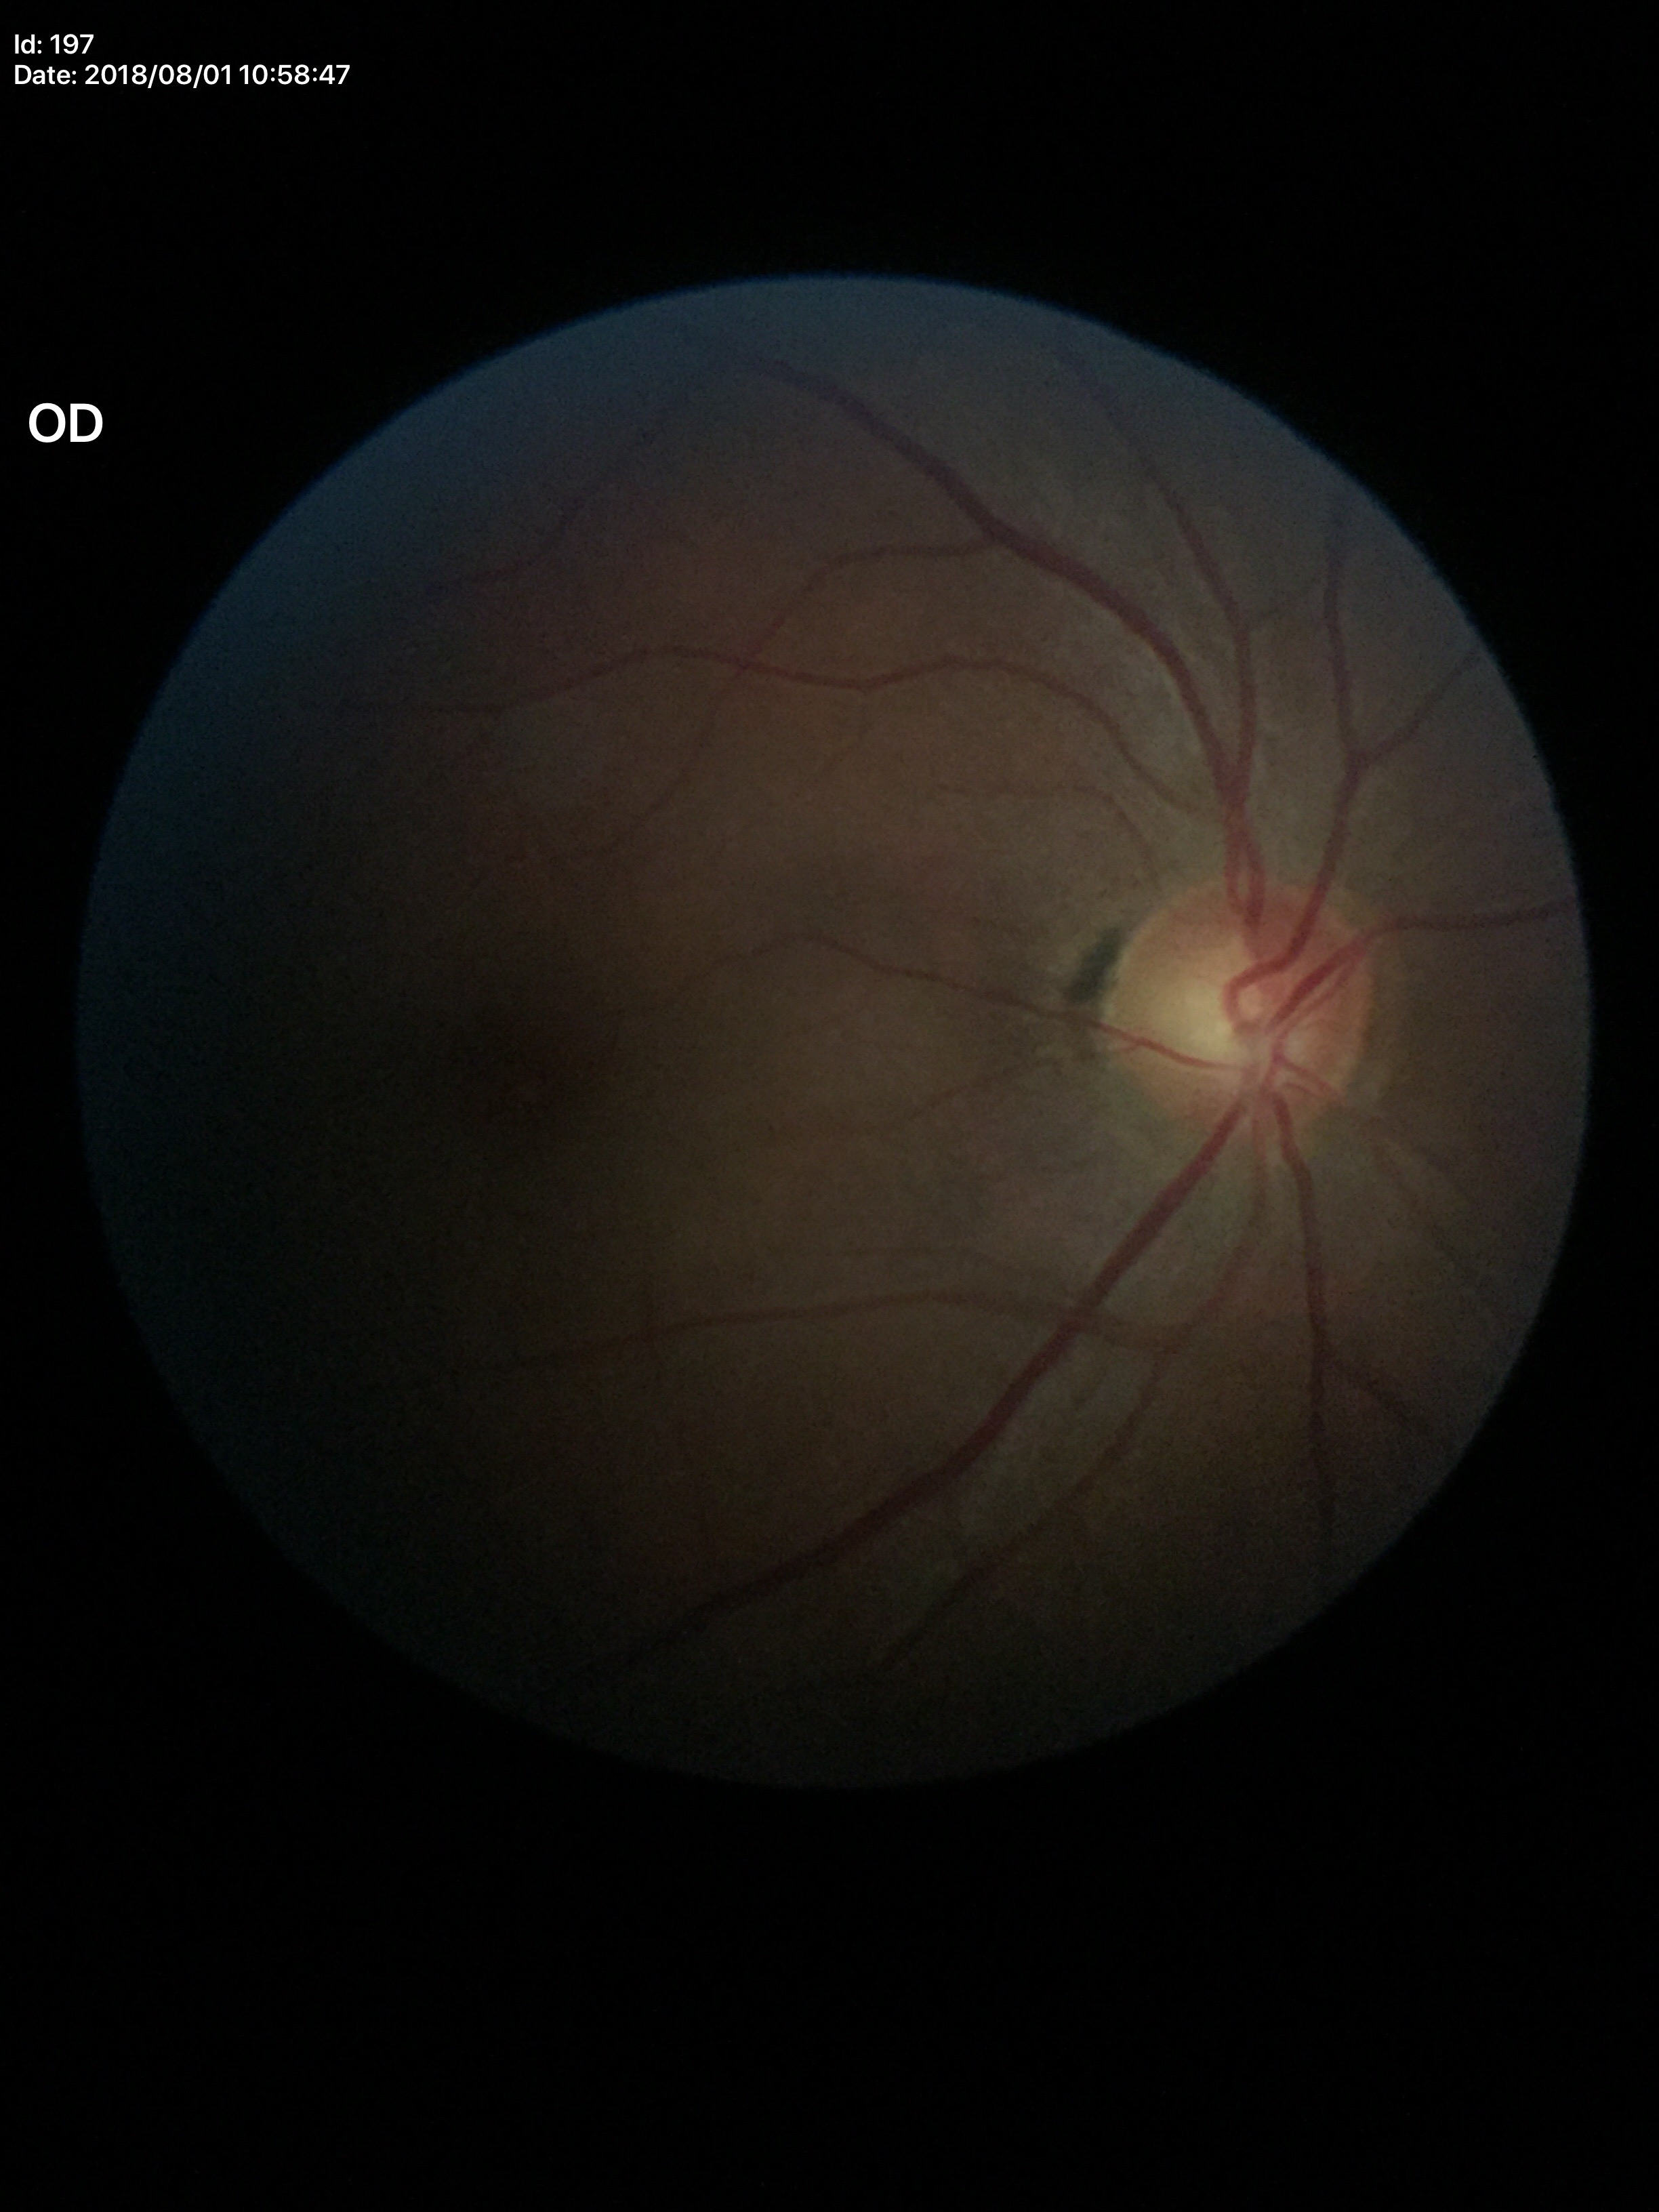 Q: Is there glaucoma suspicion?
A: negative
Q: What is the VCDR?
A: 0.51